Retinal fundus photograph, 2352 x 1568 pixels, 45-degree field of view.
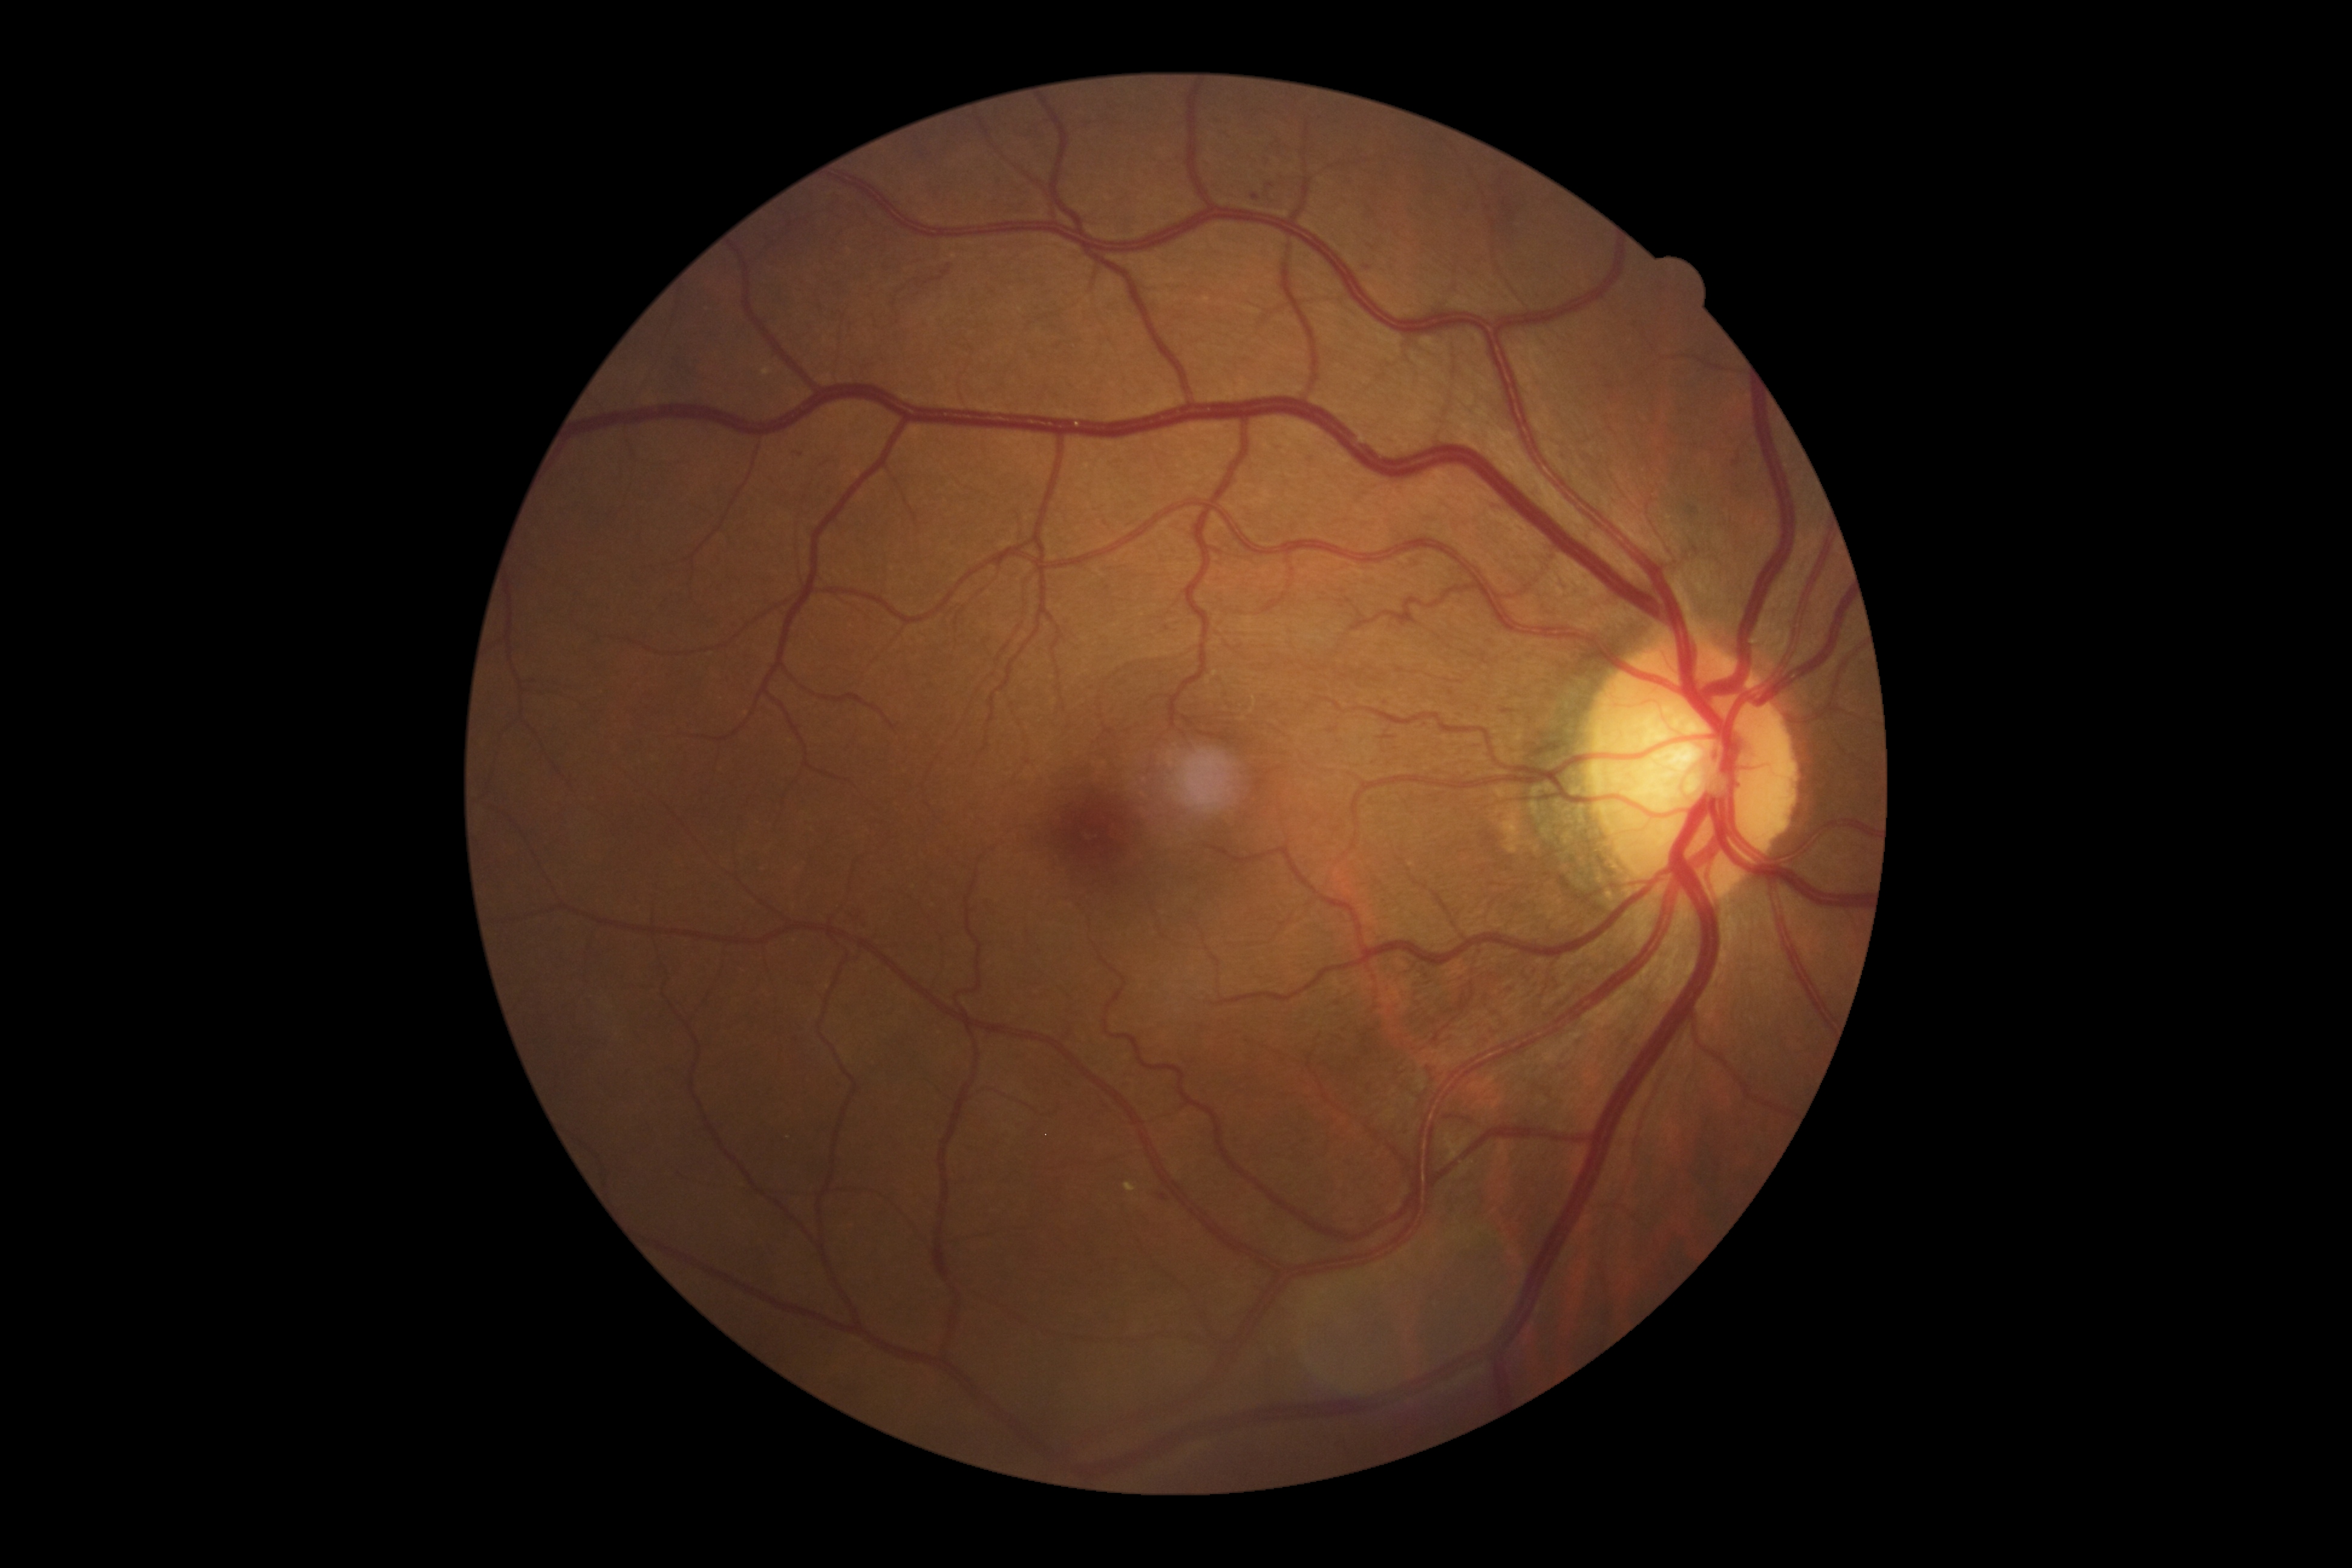
DR class: non-proliferative diabetic retinopathy.
Retinopathy grade is 3.